848x848, NIDEK AFC-230, 45 degree fundus photograph, posterior pole photograph.
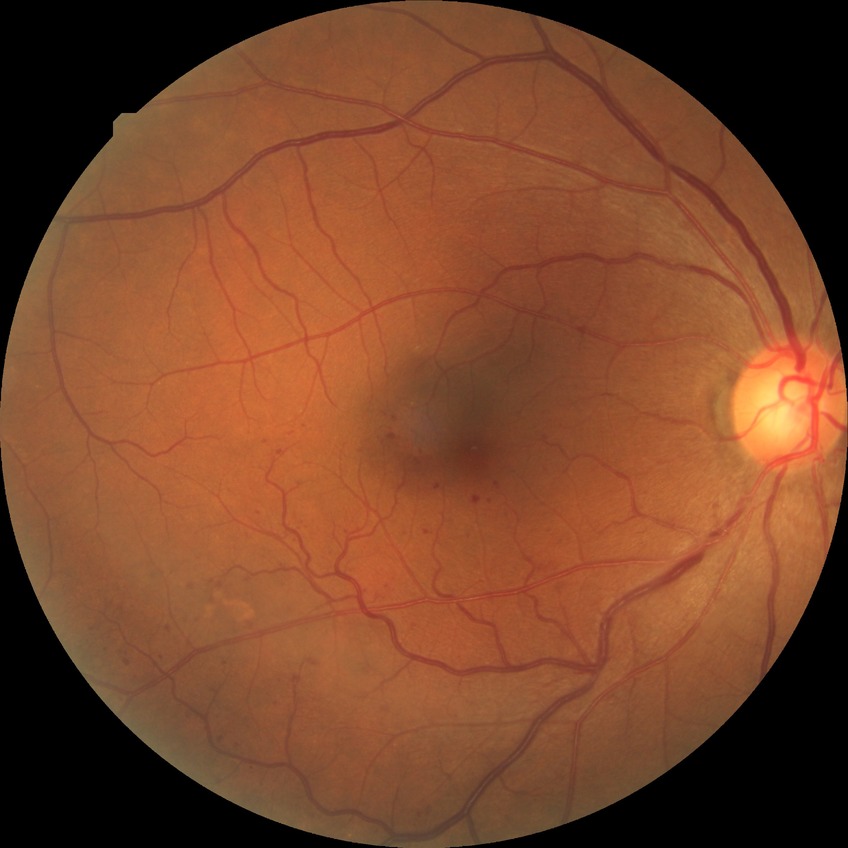

Modified Davis classification: simple diabetic retinopathy.